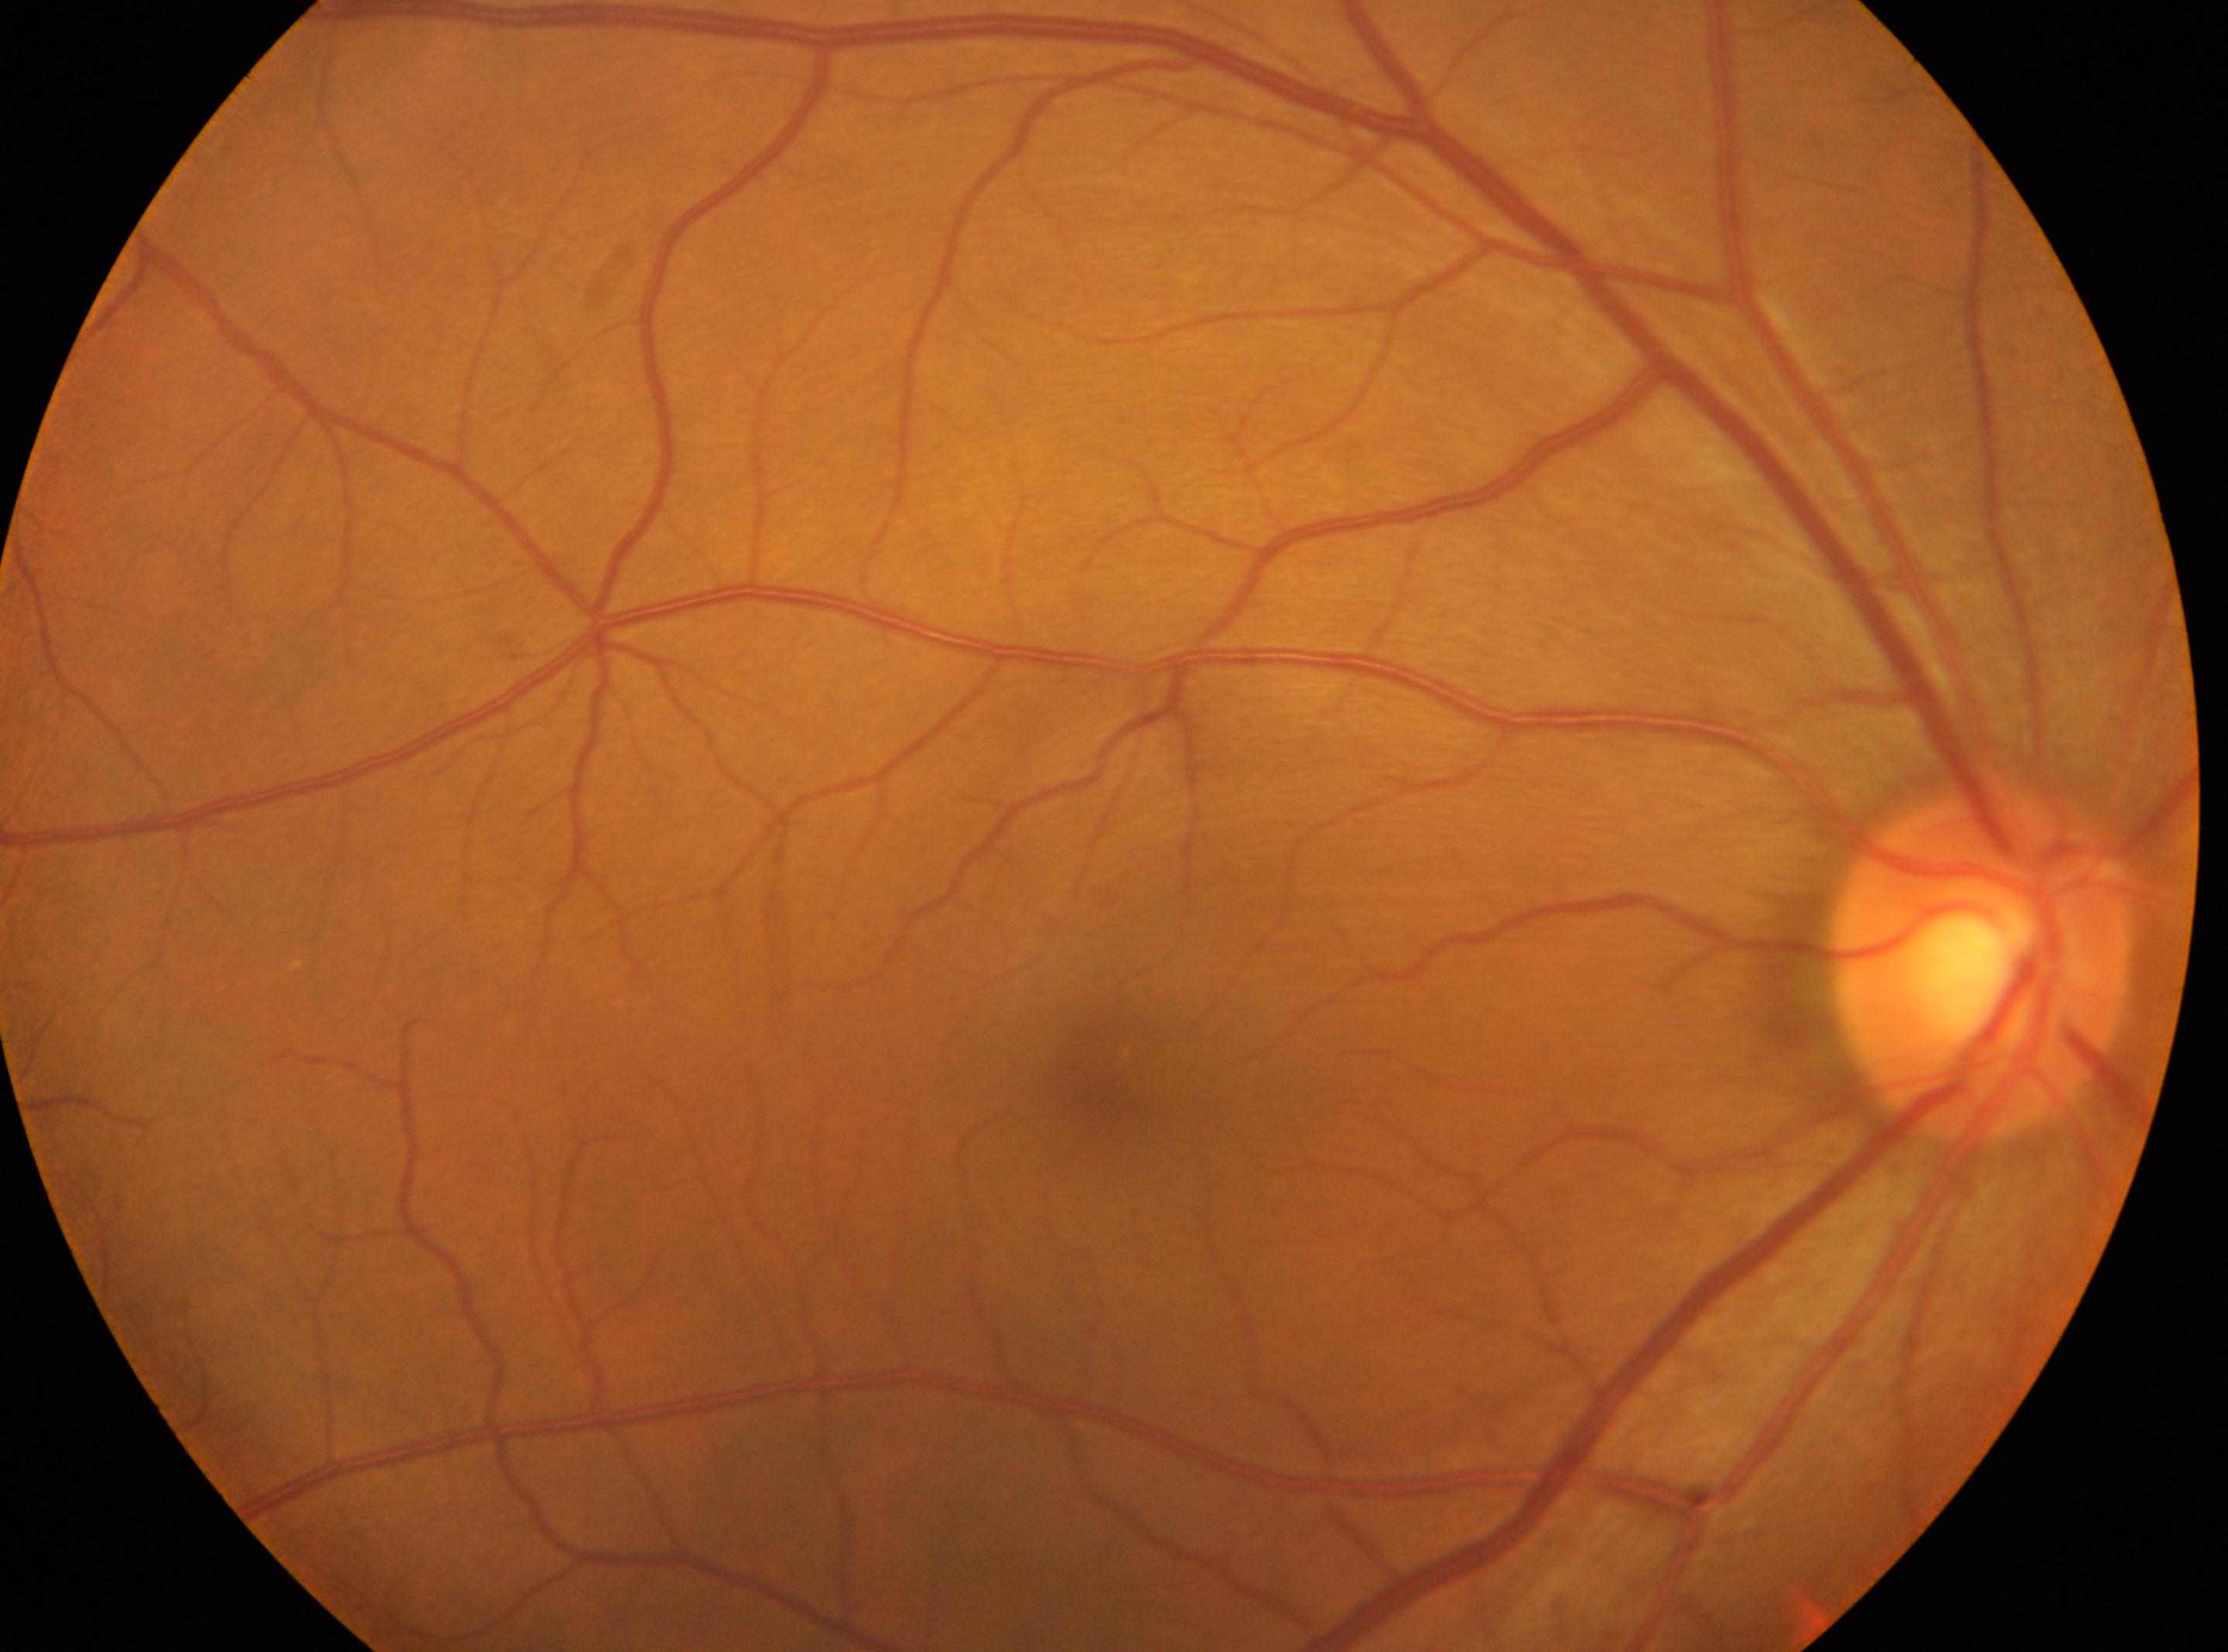
Disc center located at (1979,966). Macula center: (1105,1087). DR stage is no apparent retinopathy (grade 0). The image shows the right eye.